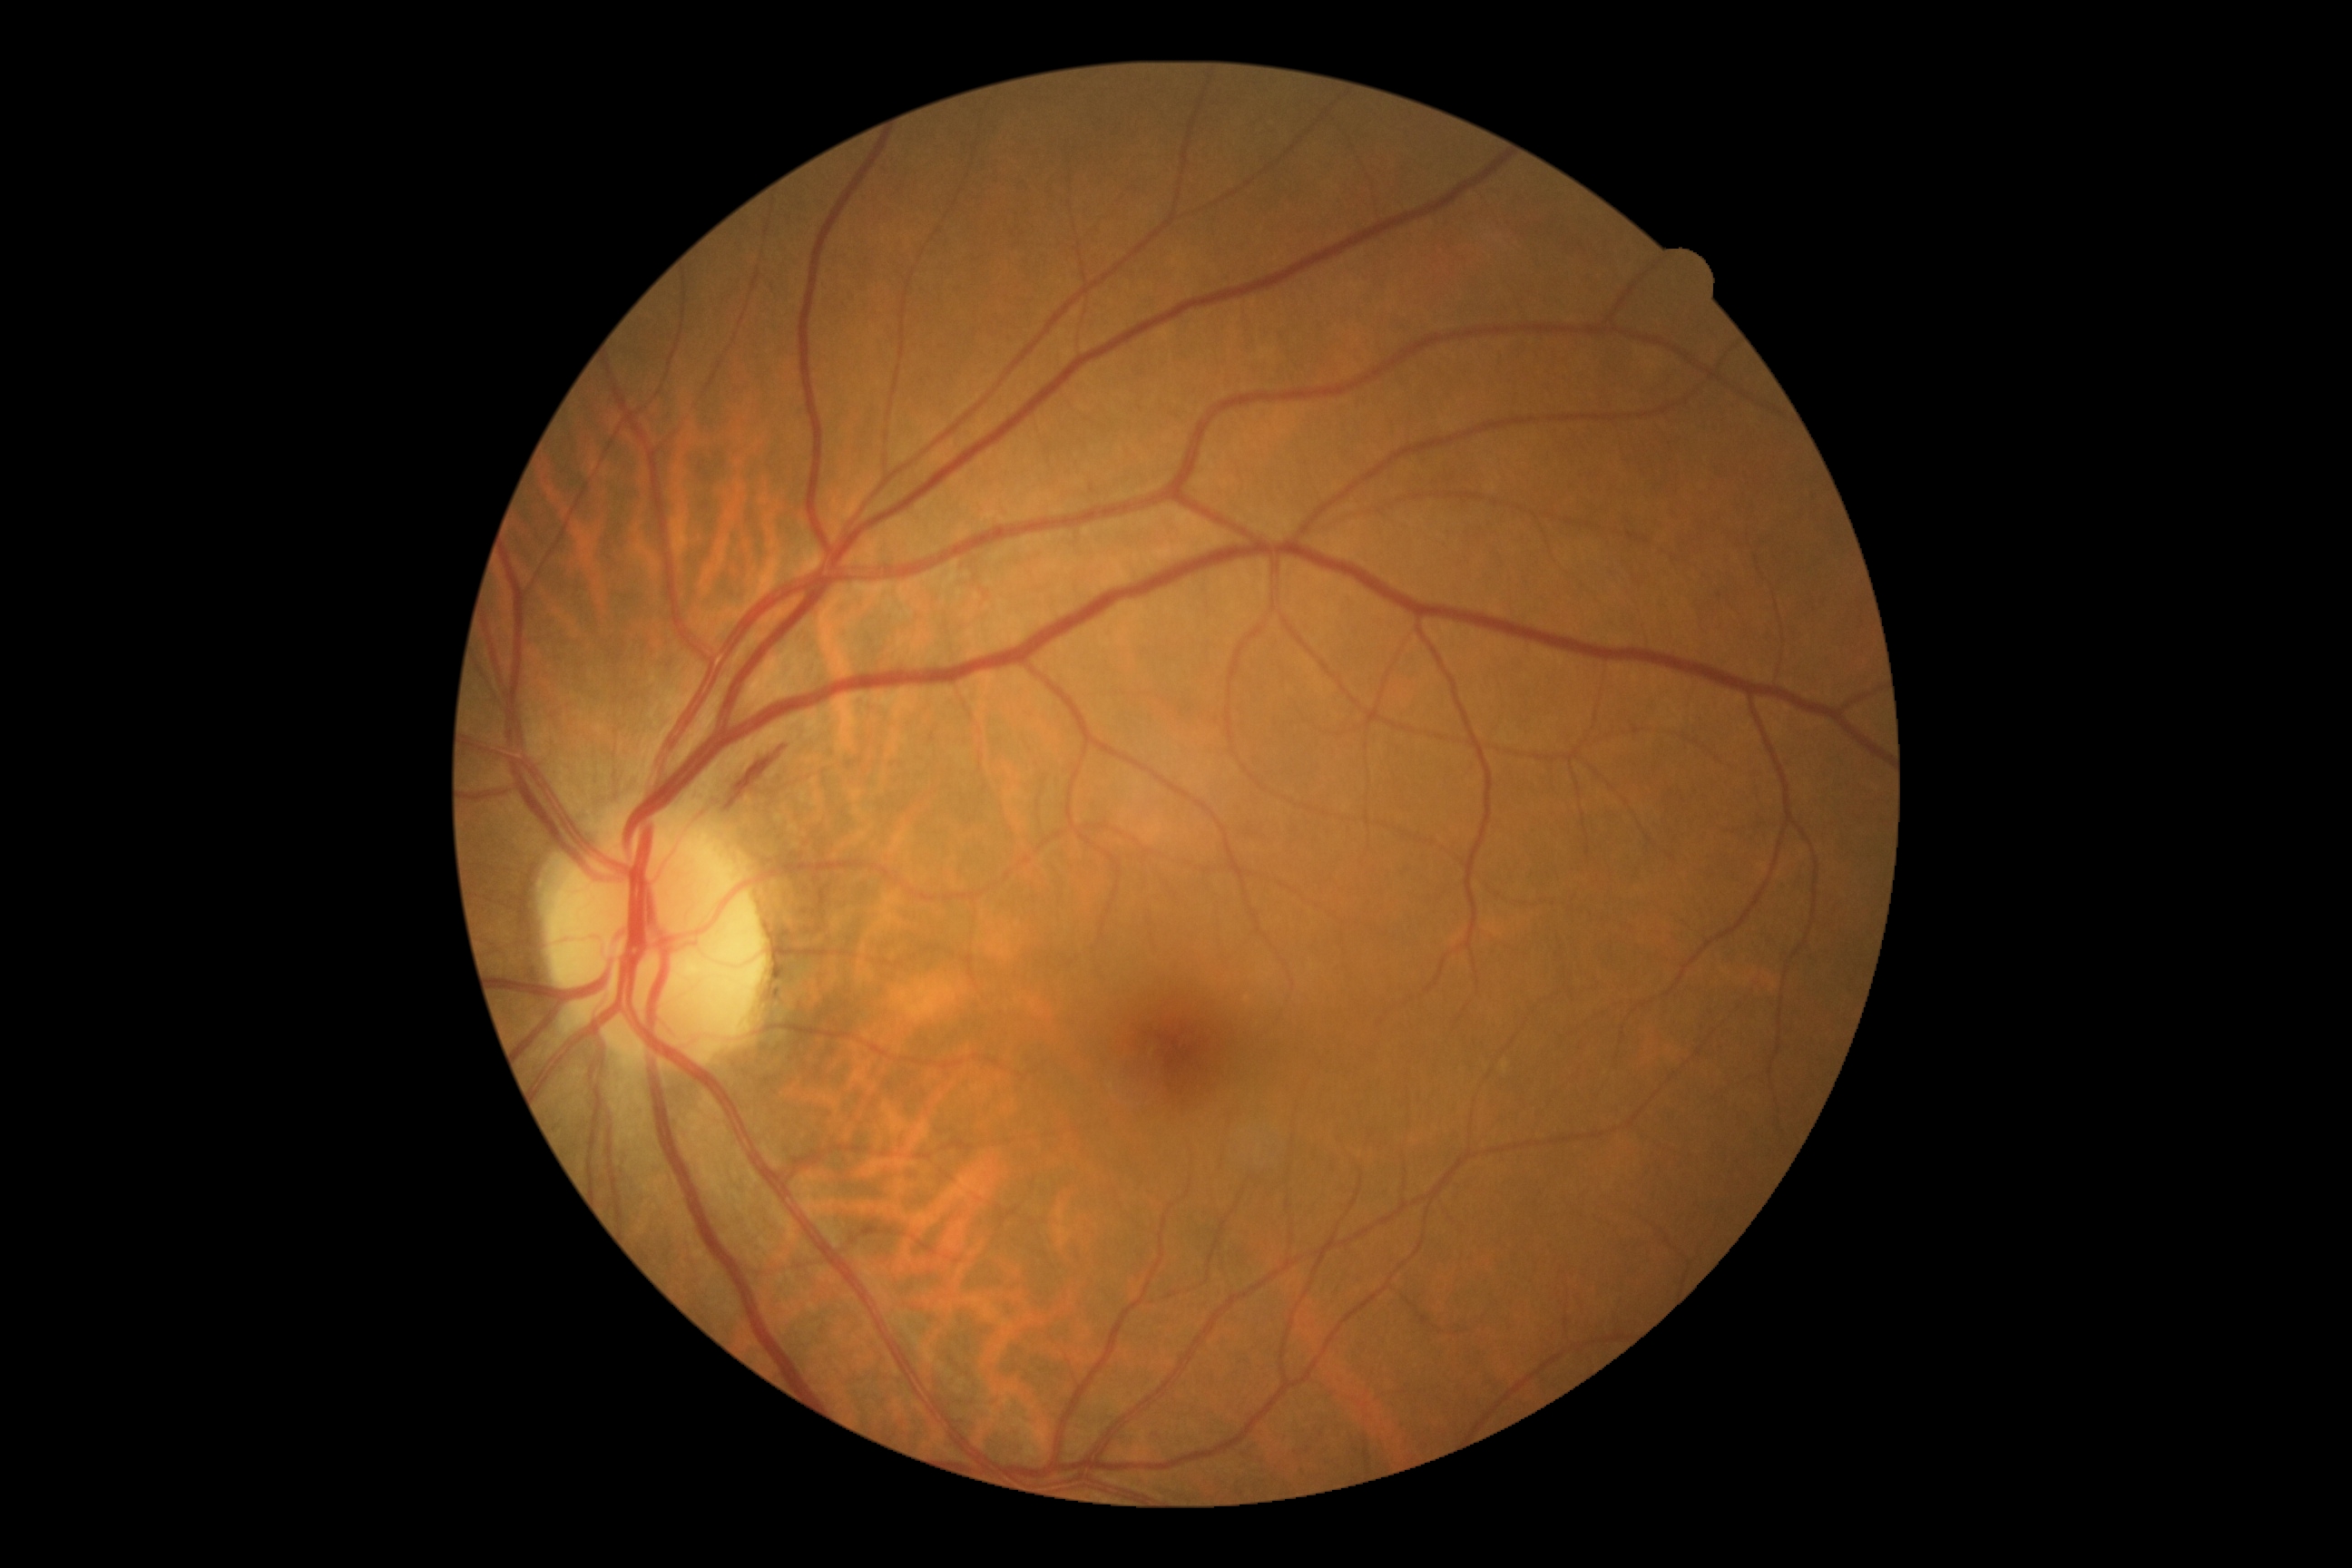 diabetic retinopathy (DR): 2/4.